Camera: Natus RetCam Envision (130° FOV) · wide-field fundus photograph from neonatal ROP screening · 1440 x 1080 pixels — 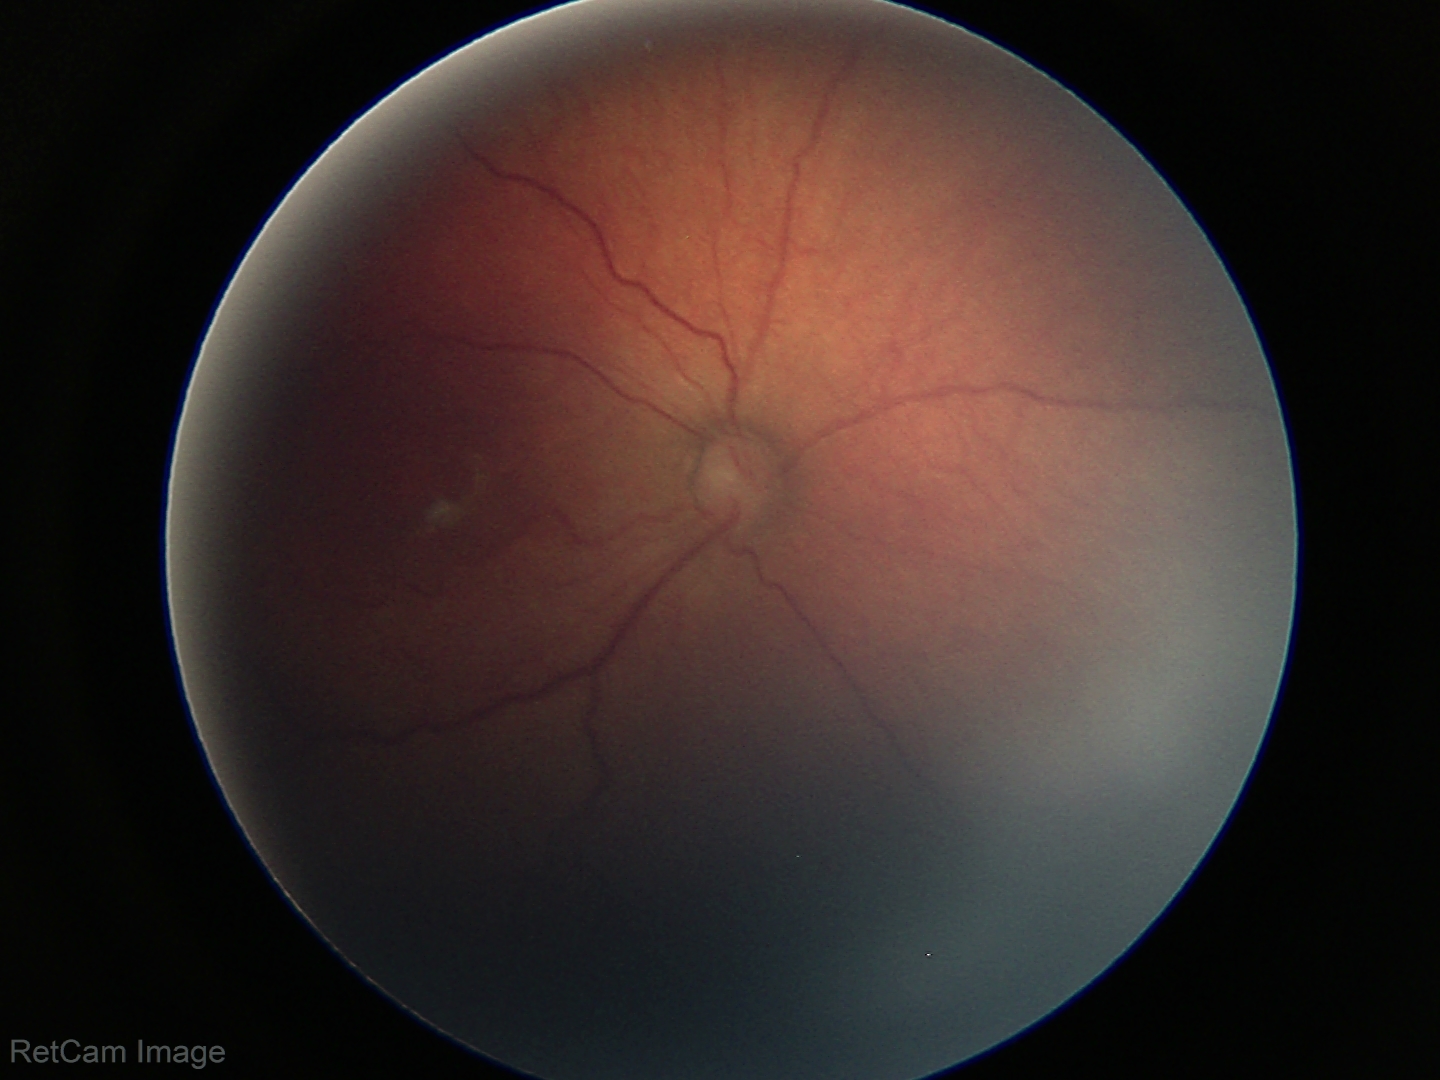 Plus disease absent.
Screening series with retinopathy of prematurity stage 3.